2352 by 1568 pixels. FOV: 45 degrees
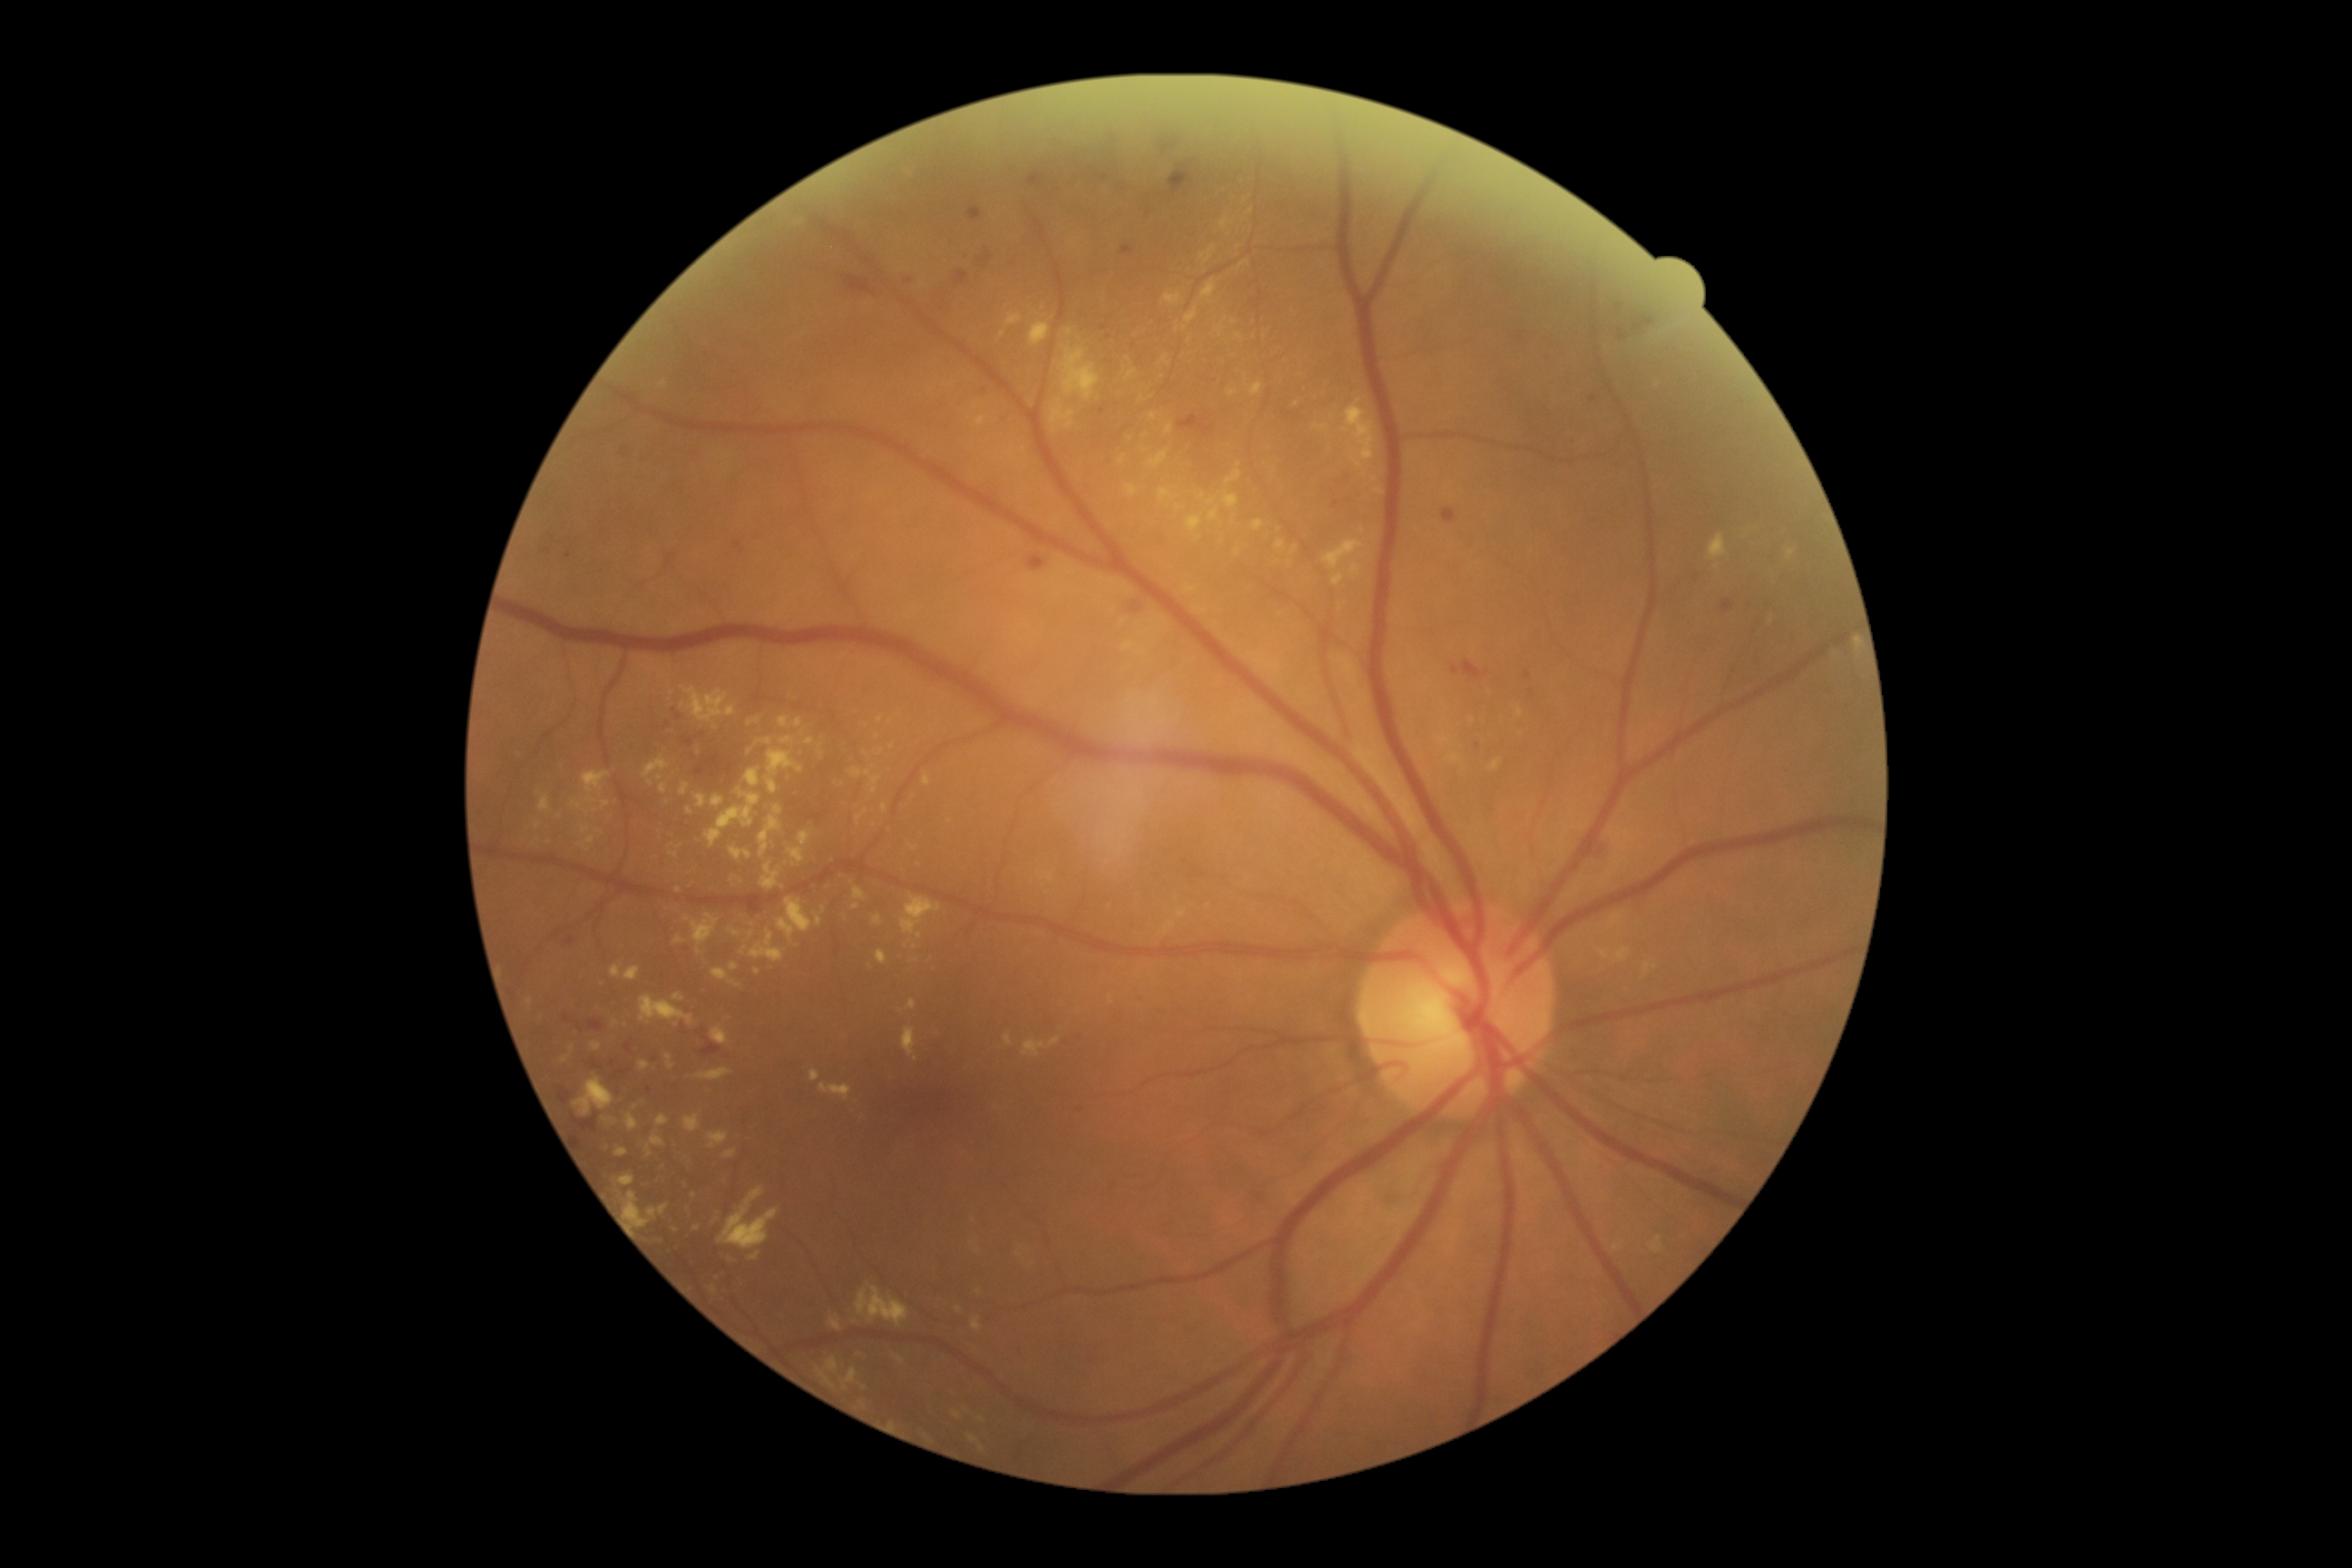
Diabetic retinopathy grade is 2 (moderate NPDR) — more than just microaneurysms but less than severe NPDR.
Hard exudates are present, including at bbox(685, 1115, 701, 1133); bbox(778, 897, 812, 943); bbox(1228, 387, 1237, 398); bbox(805, 738, 816, 745); bbox(883, 803, 888, 814); bbox(1293, 545, 1298, 554); bbox(1050, 1037, 1063, 1046); bbox(723, 1150, 738, 1161); bbox(1226, 471, 1242, 485); bbox(856, 810, 868, 825); bbox(1253, 520, 1266, 531); bbox(696, 1068, 732, 1083).
Hard exudates (small, approximate centers) near (x=688, y=918); (x=1124, y=621); (x=1297, y=404); (x=679, y=846); (x=1363, y=530); (x=975, y=406).